130° field of view (Clarity RetCam 3); 640 by 480 pixels; infant wide-field fundus photograph.
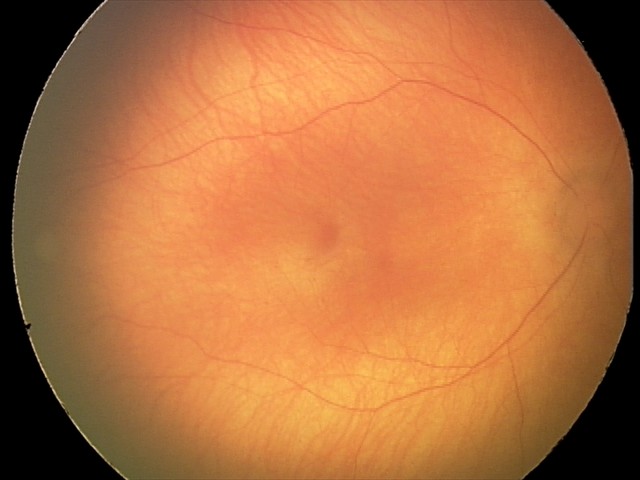

Without plus disease.
Screening series with retinopathy of prematurity (ROP) stage 0.